640 x 480 pixels. Clarity RetCam 3, 130° FOV. Wide-field fundus image from infant ROP screening.
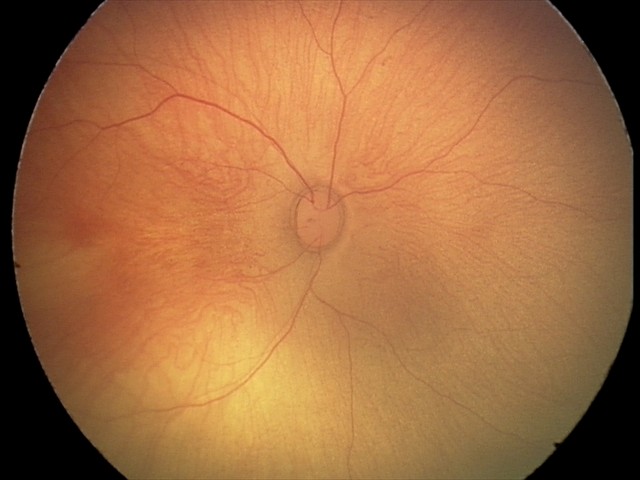
Impression: retinal hemorrhages.